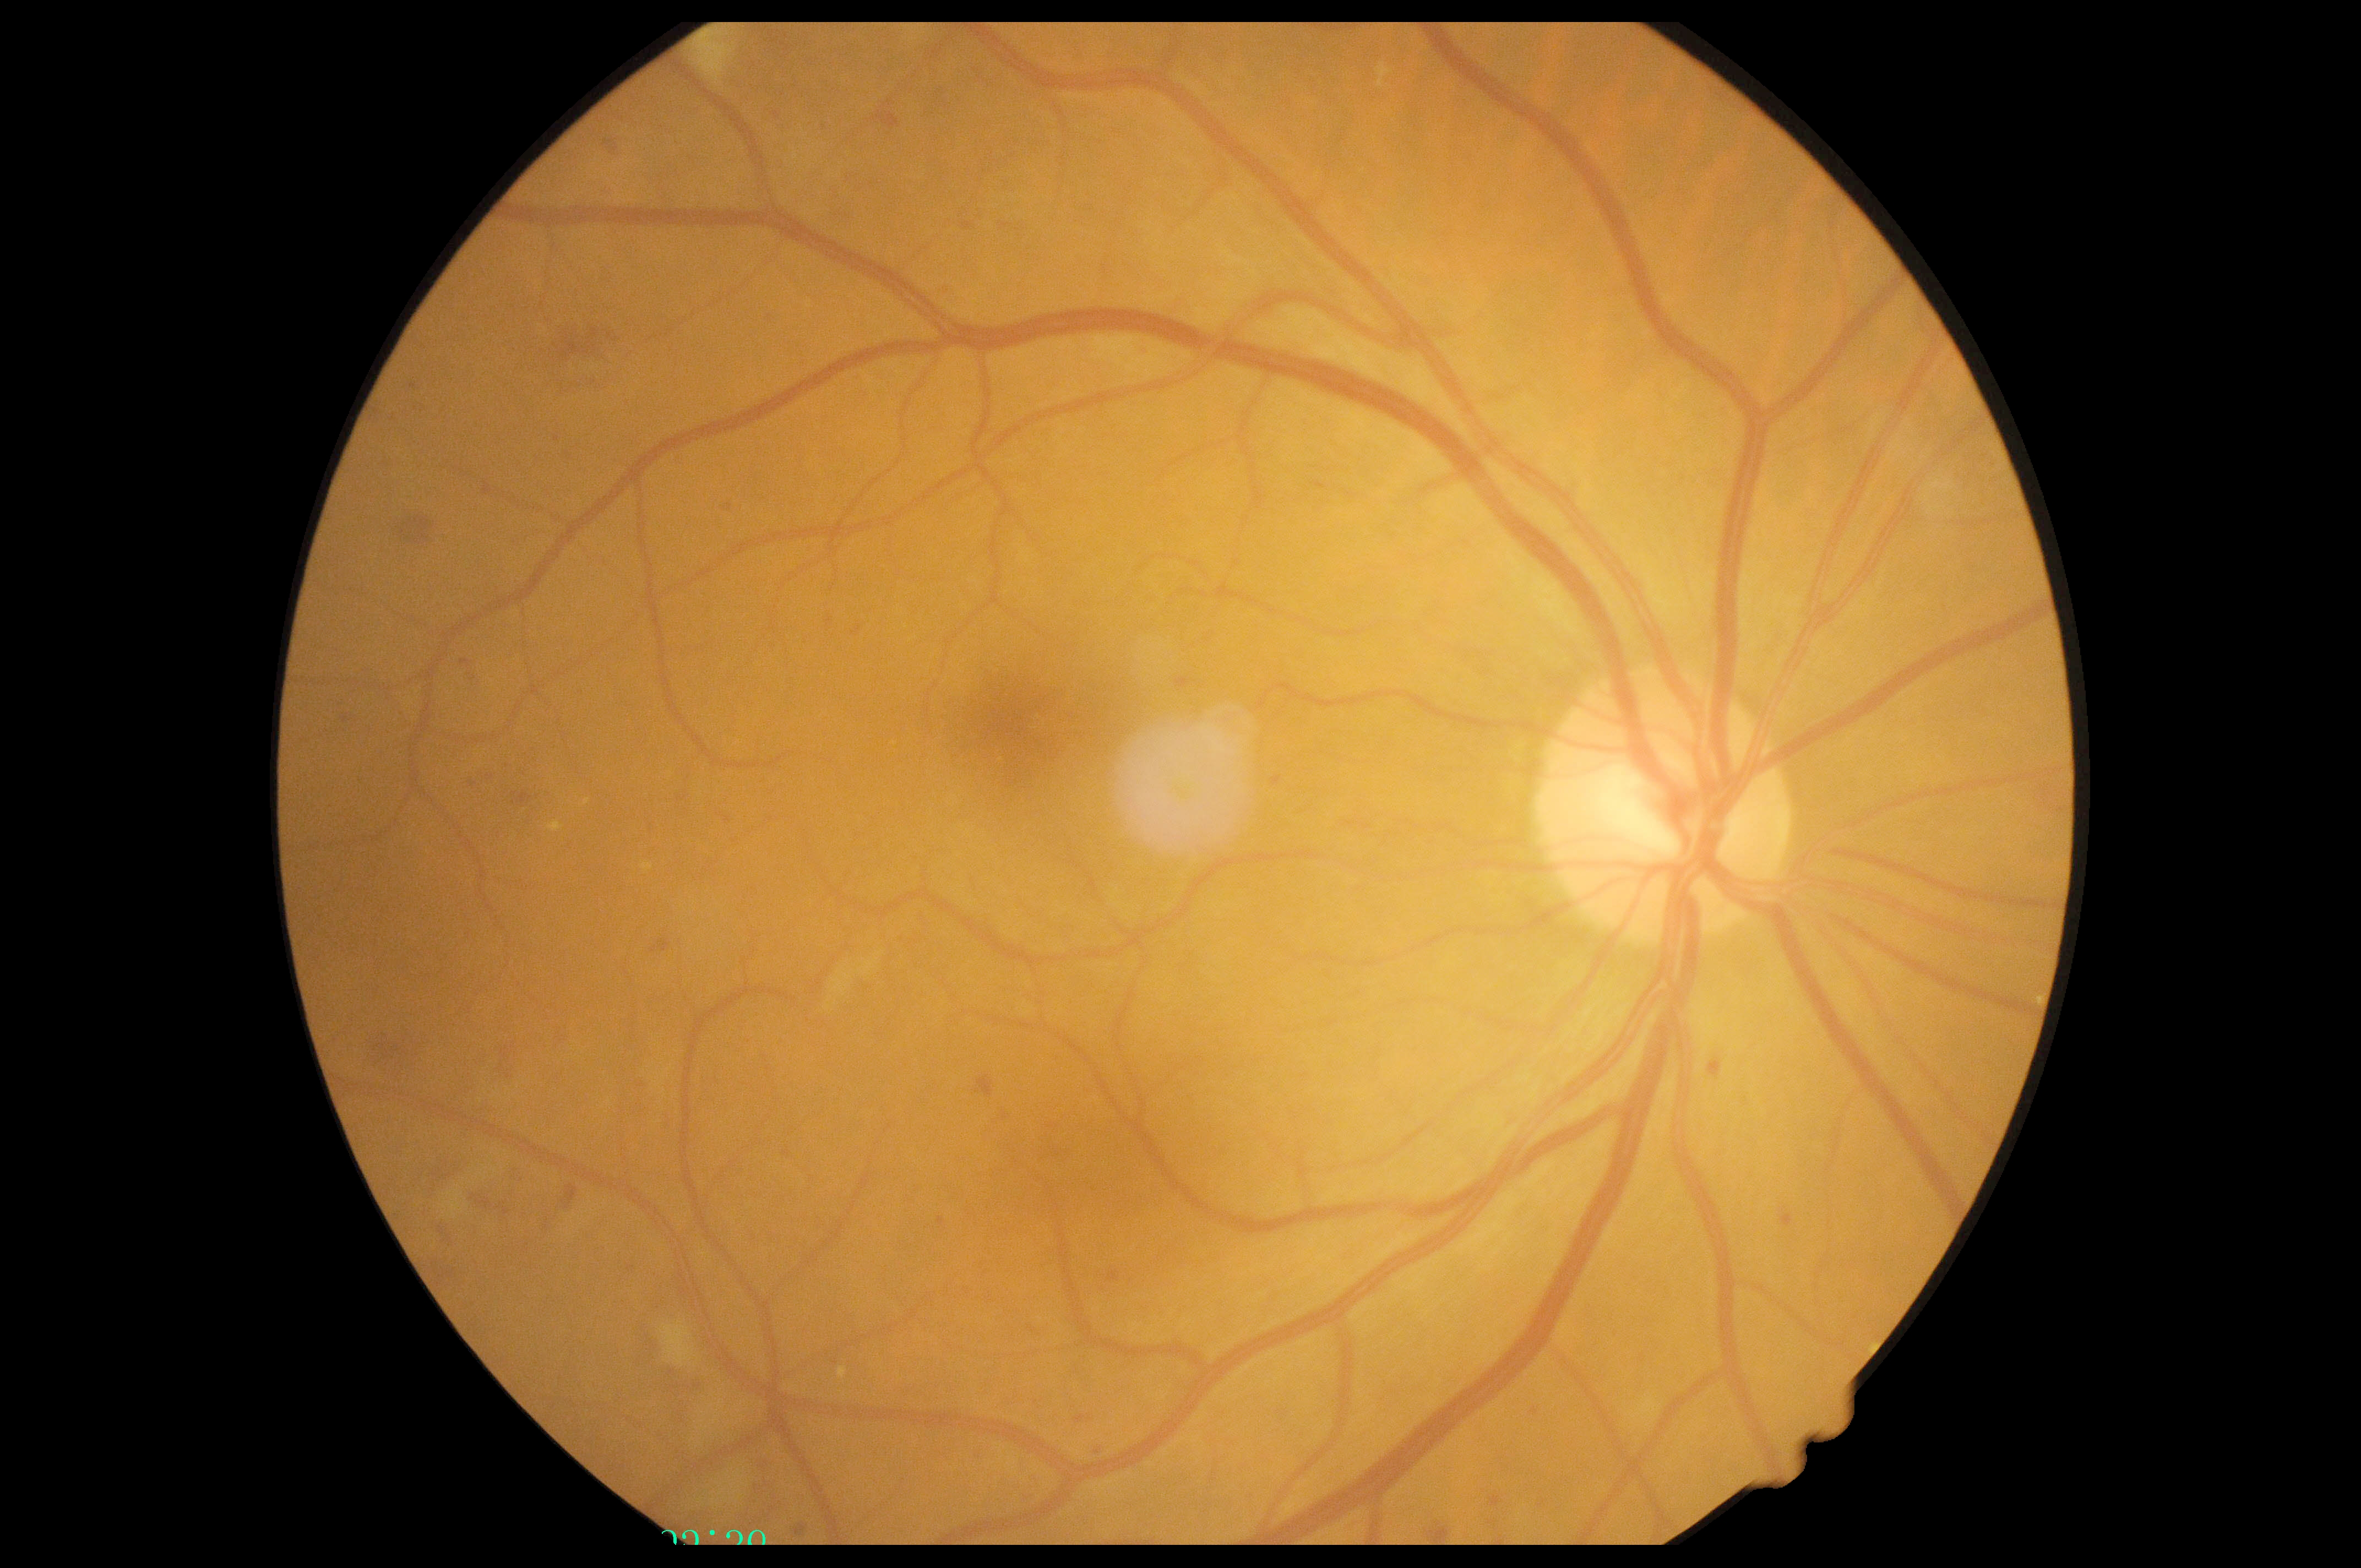

DR severity = moderate NPDR (grade 2).